45° field of view:
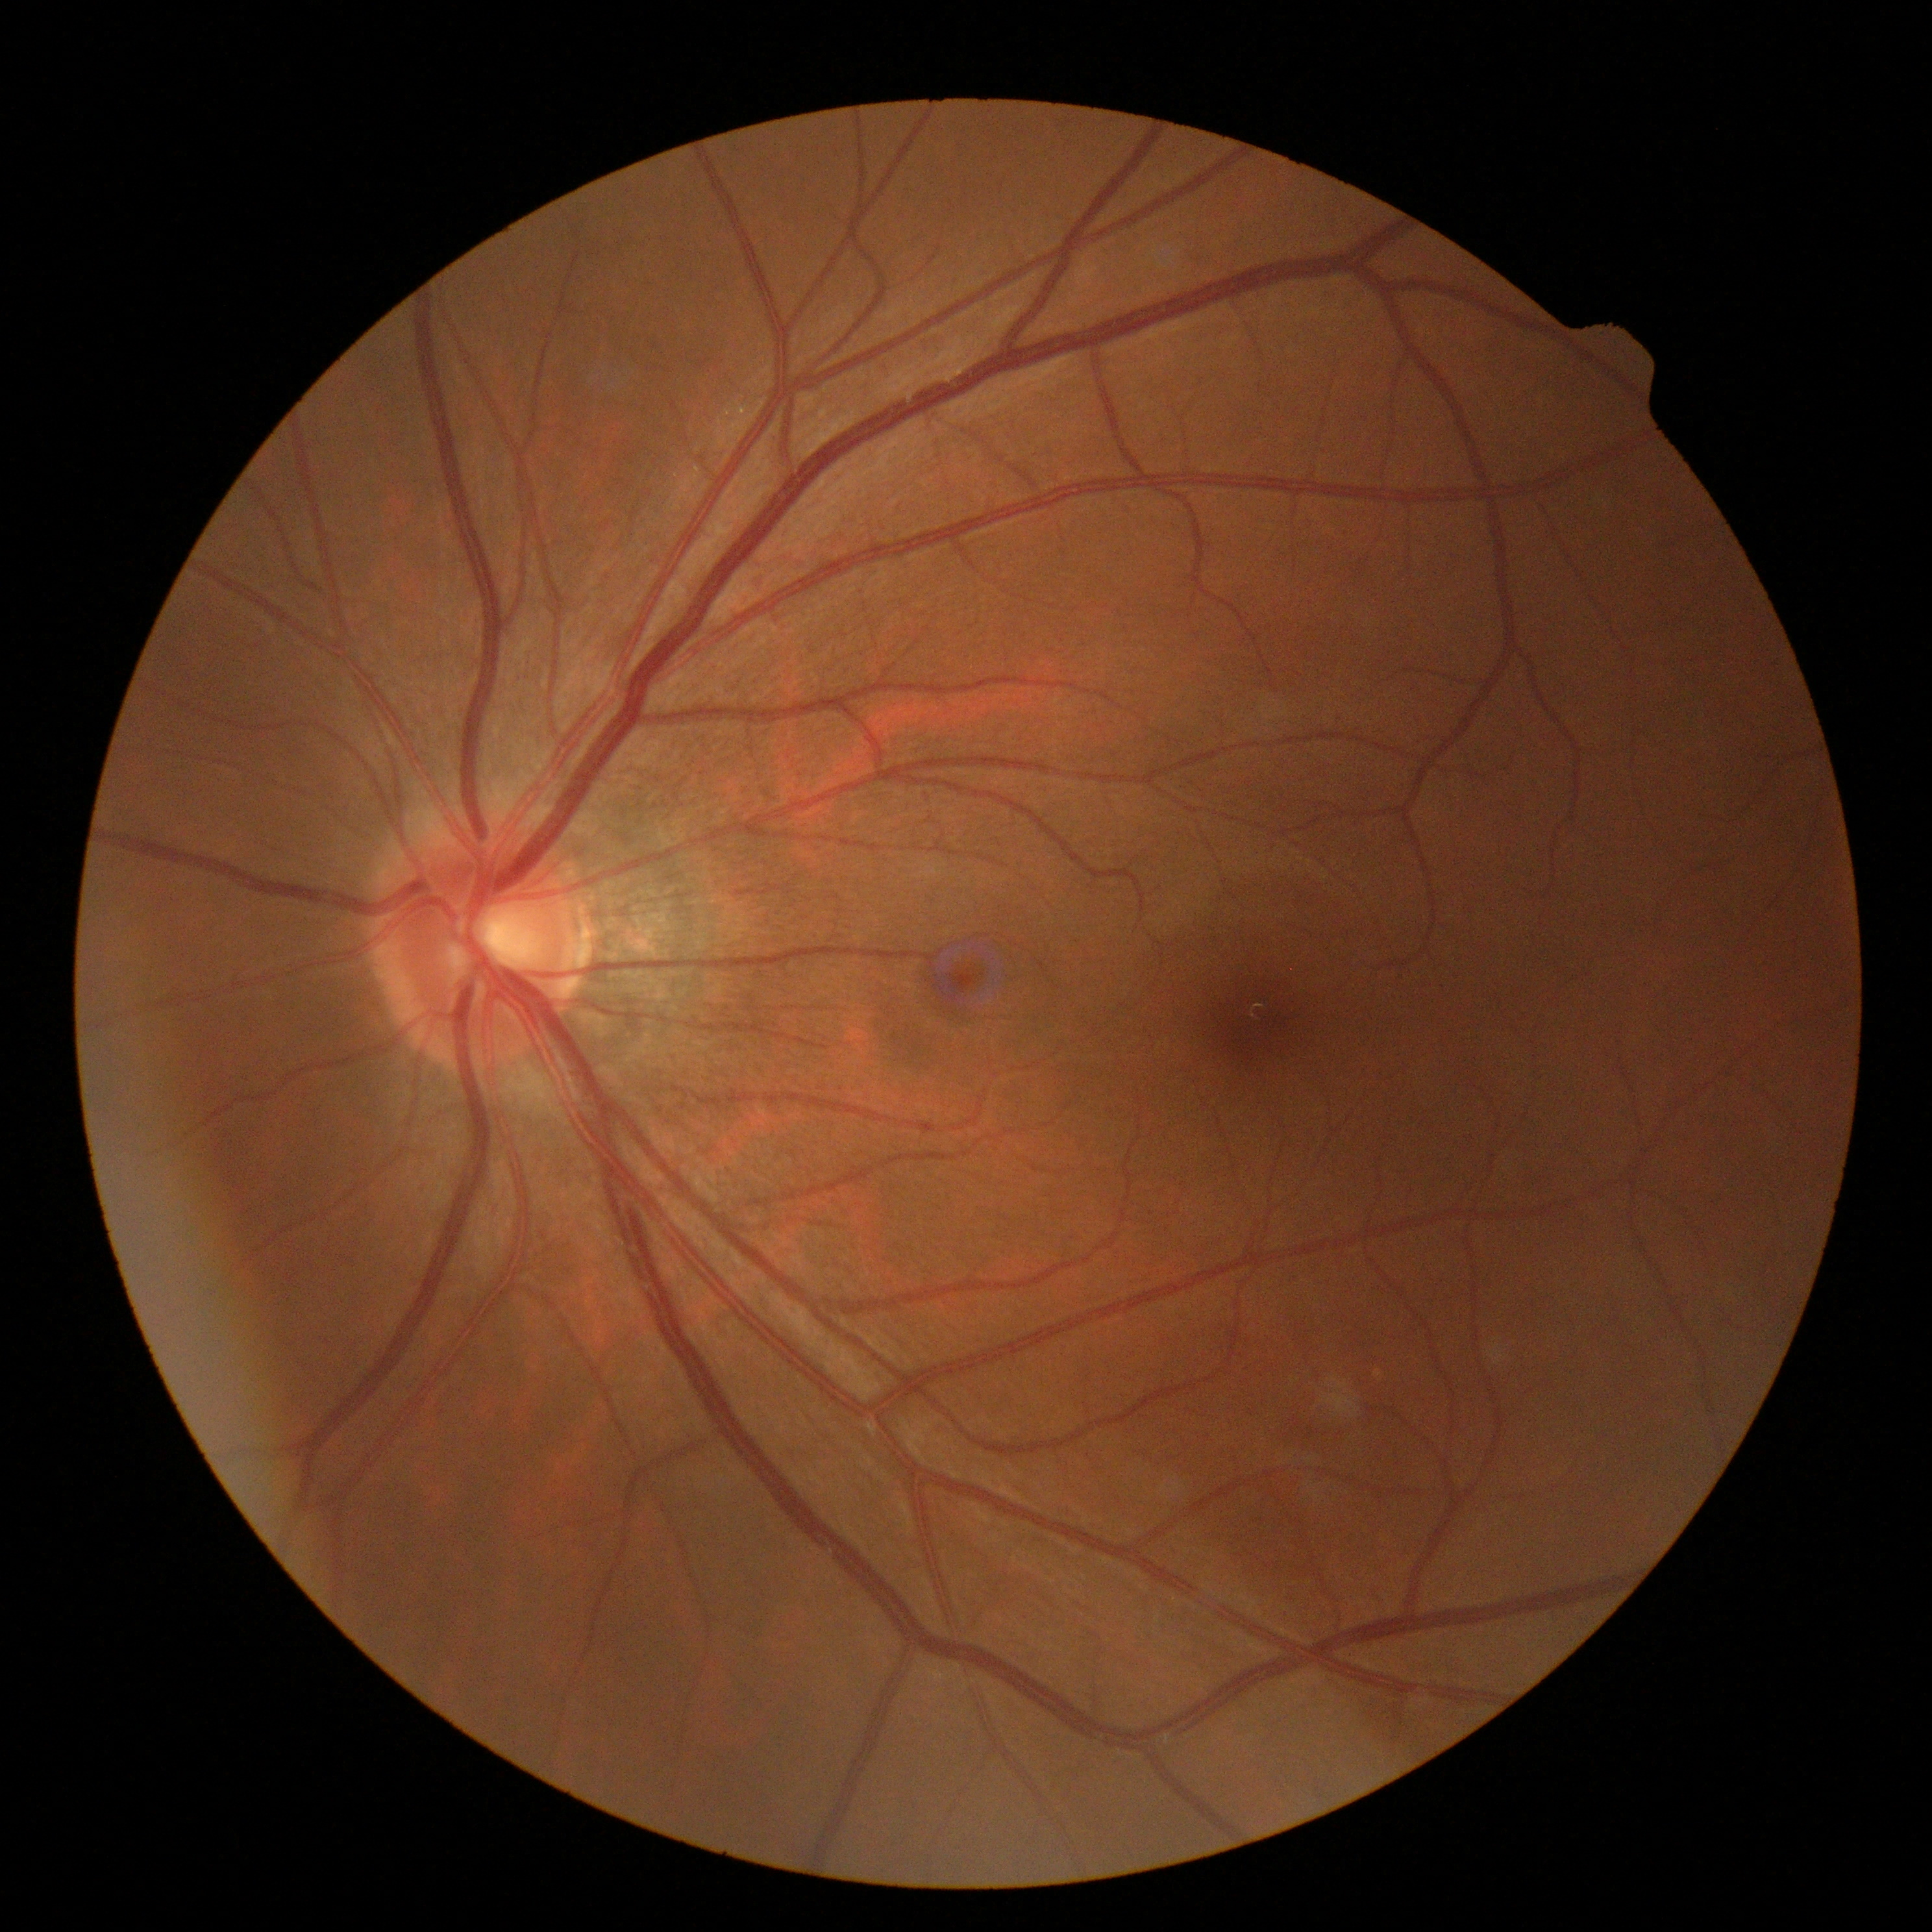 Retinopathy: grade 0 (no apparent retinopathy).
No DR findings.